Retinal fundus photograph
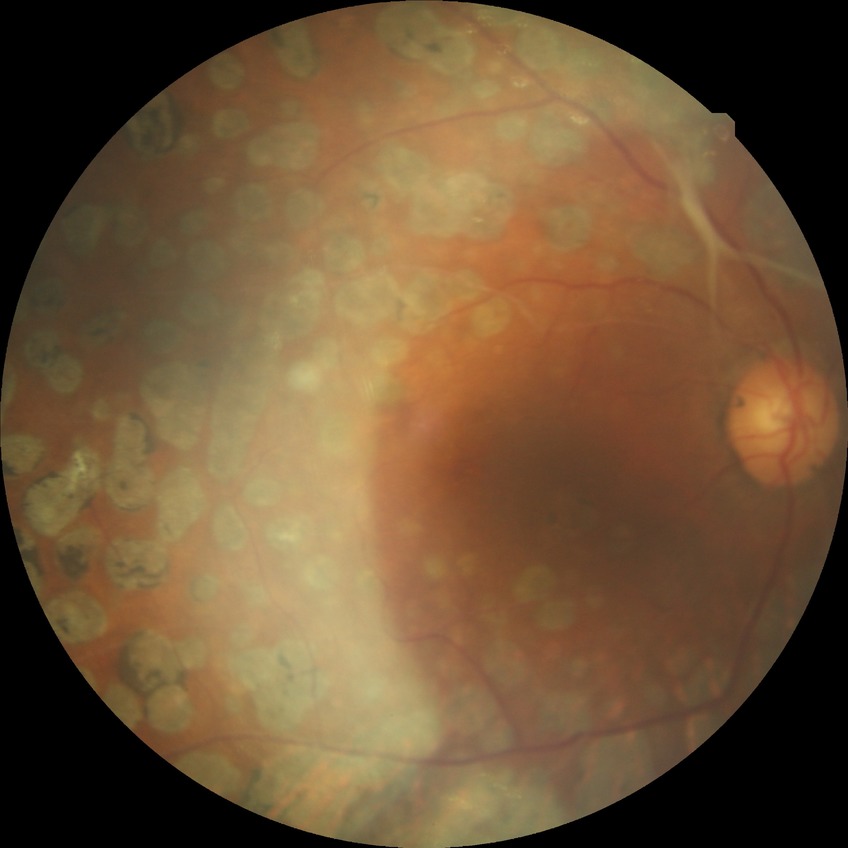
diabetic retinopathy stage: proliferative diabetic retinopathy.